Infant wide-field retinal image; 1440x1080.
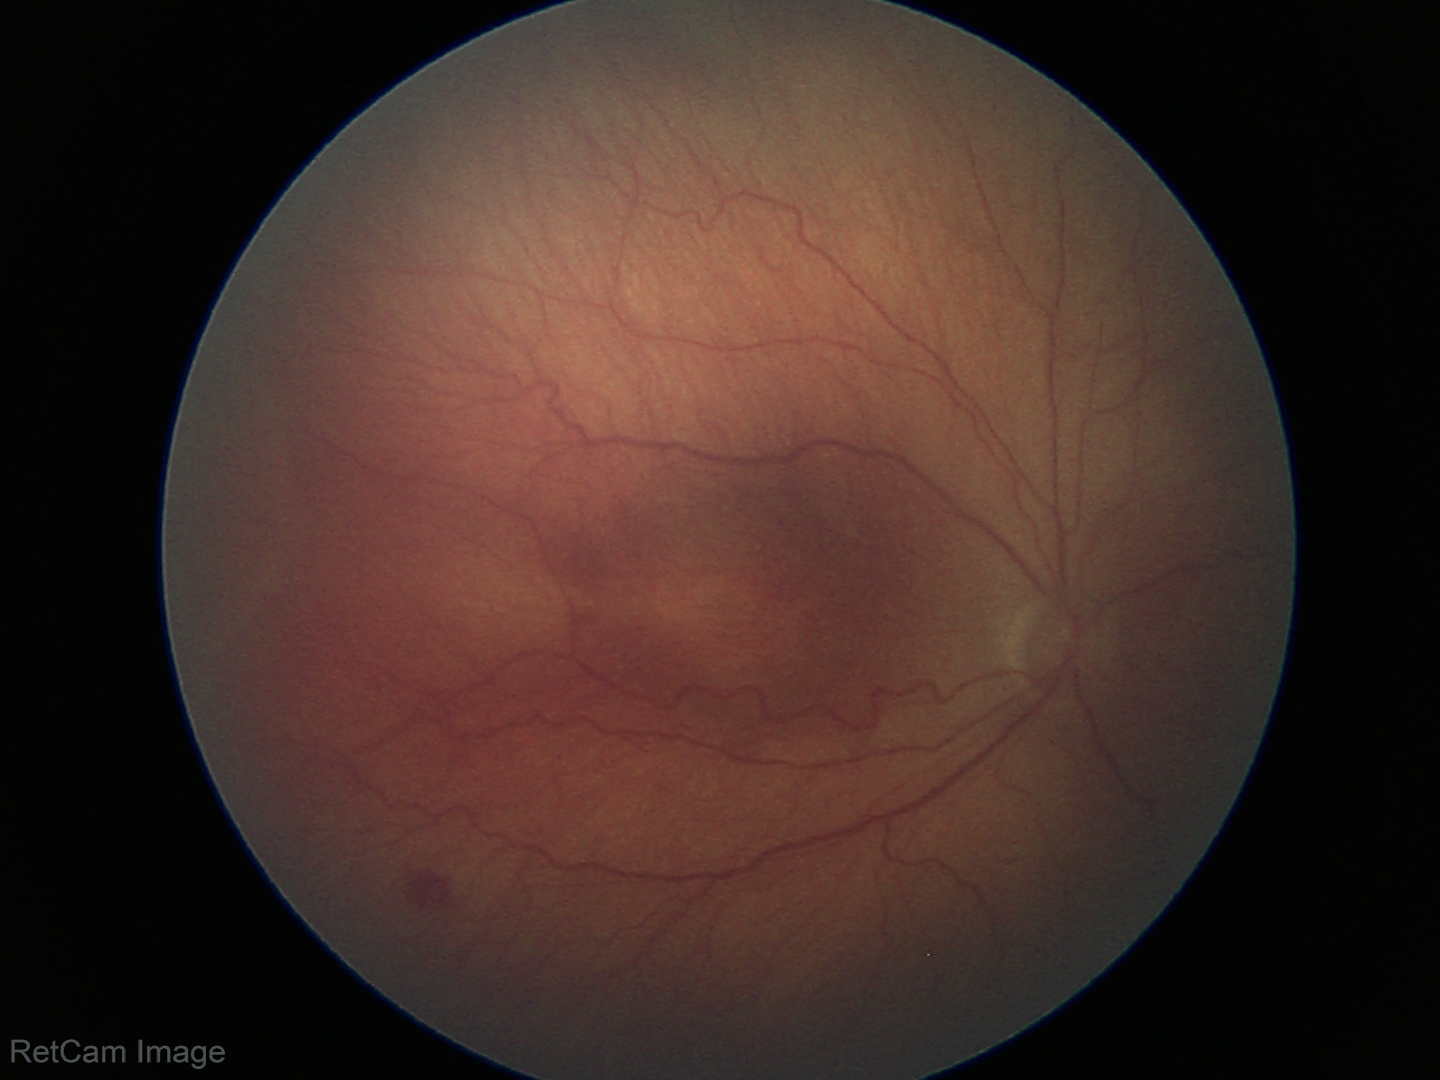
Plus disease absent. Series diagnosed as ROP stage 3.